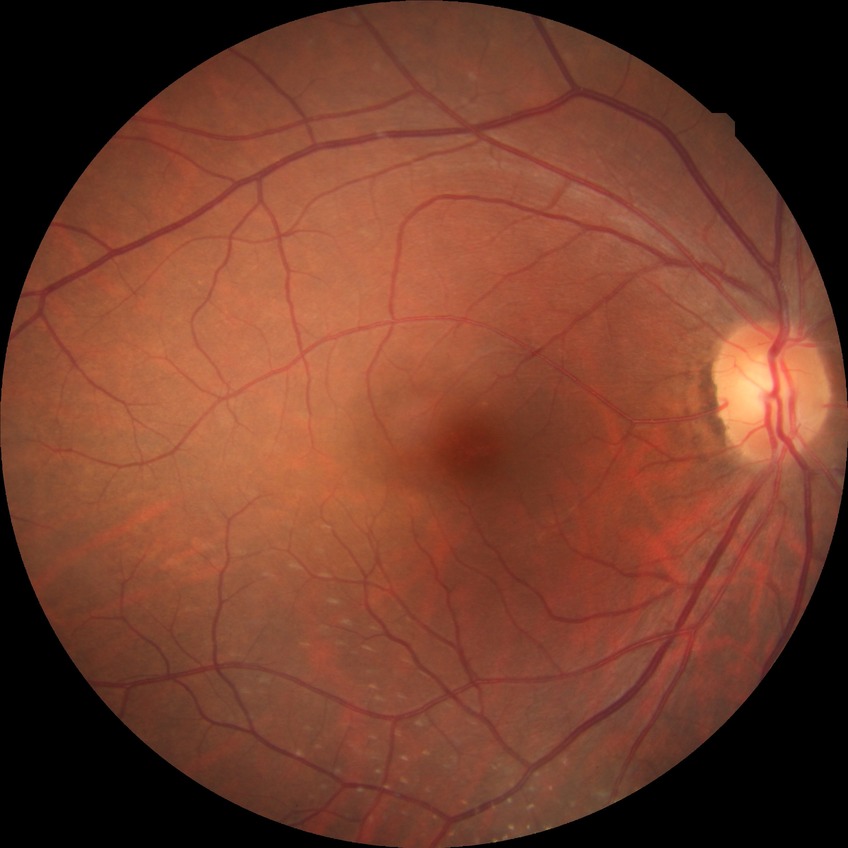
  davis_grade: NDR (no diabetic retinopathy)